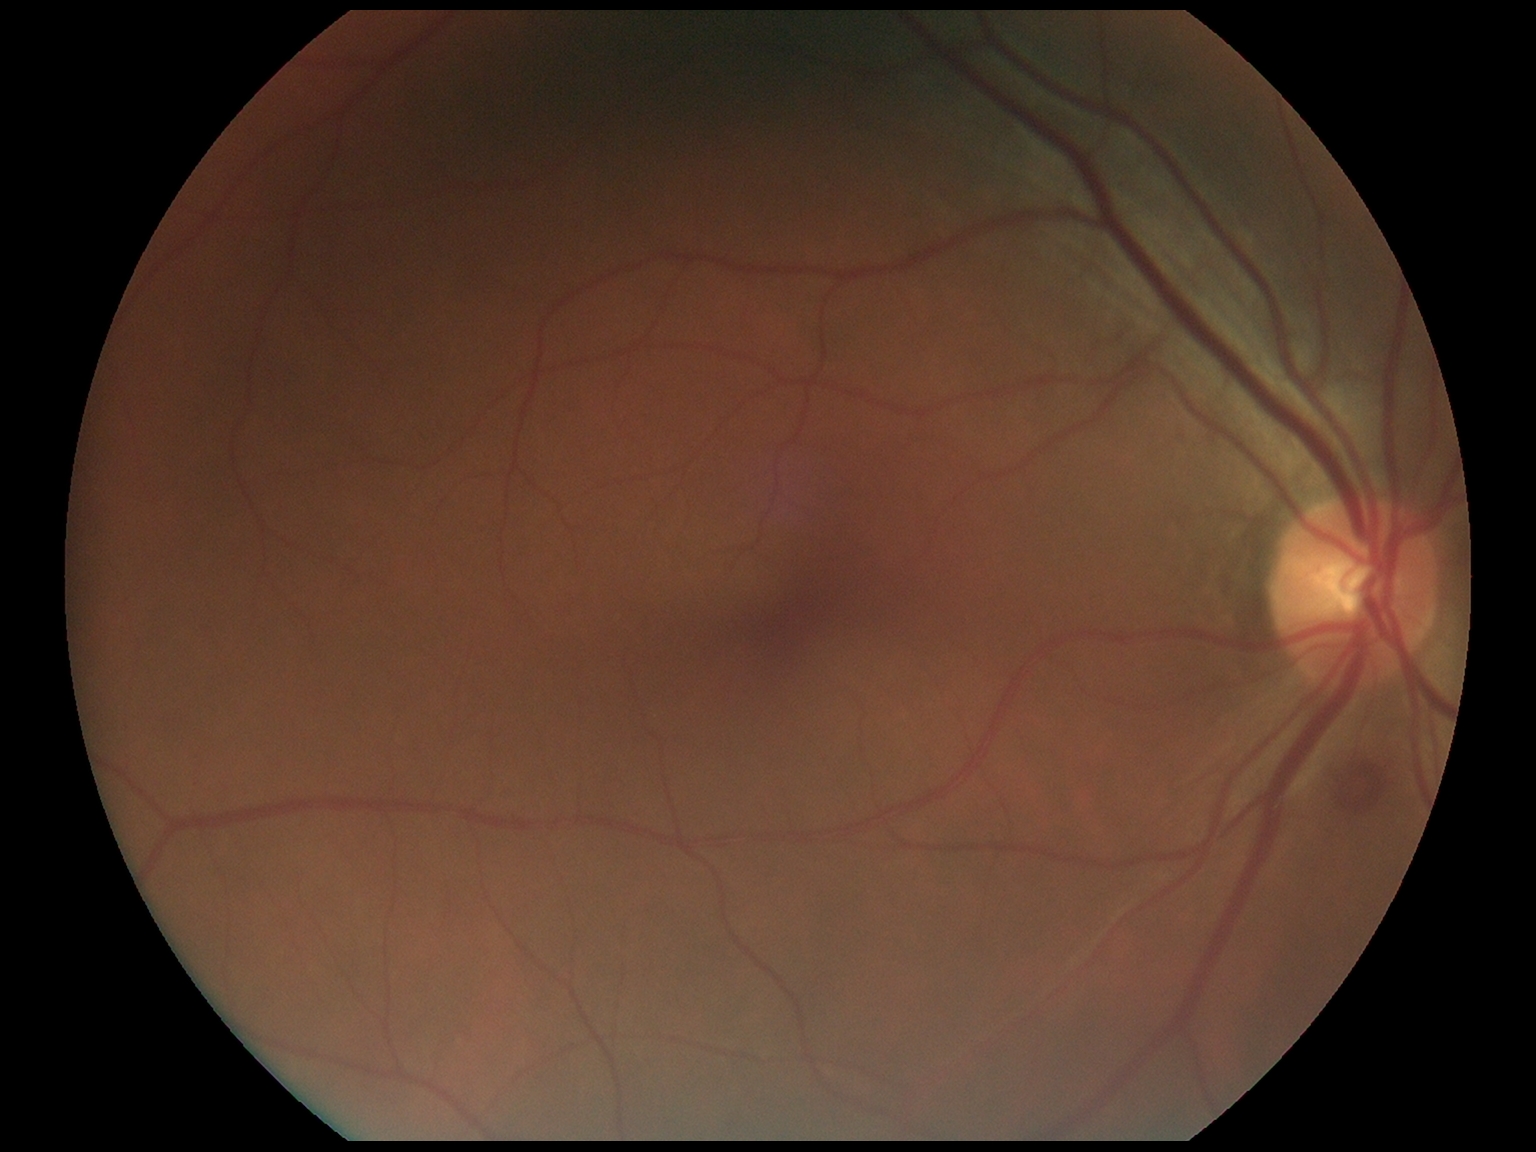
{"dr_category": "non-proliferative diabetic retinopathy", "dr_grade": "2"}